CFP. Camera: NIDEK AFC-230. Nonmydriatic fundus photograph. 45° FOV: 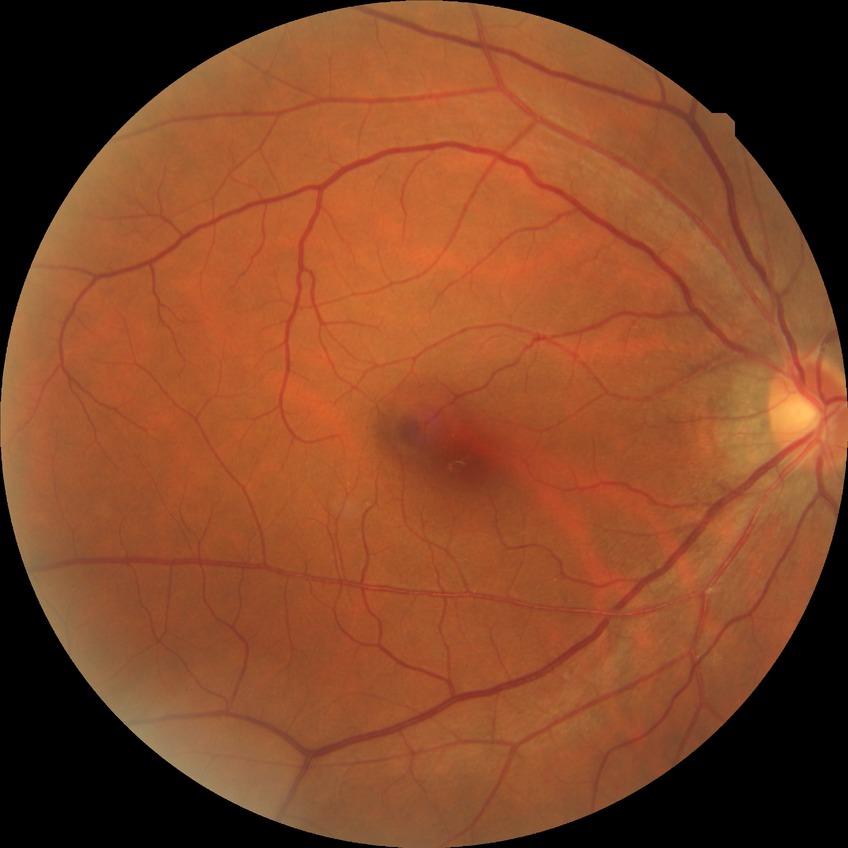 diabetic retinopathy (DR) = no diabetic retinopathy (NDR).